DR severity per modified Davis staging: 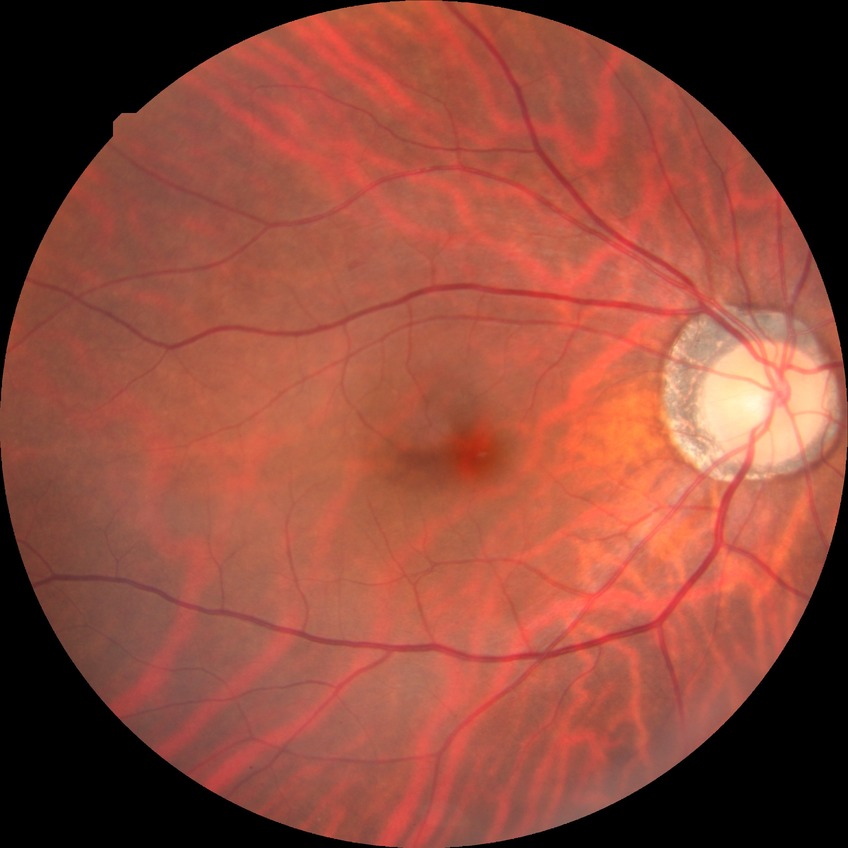 Diabetic retinopathy (DR): simple diabetic retinopathy (SDR).